NIDEK AFC-230 fundus camera, nonmydriatic.
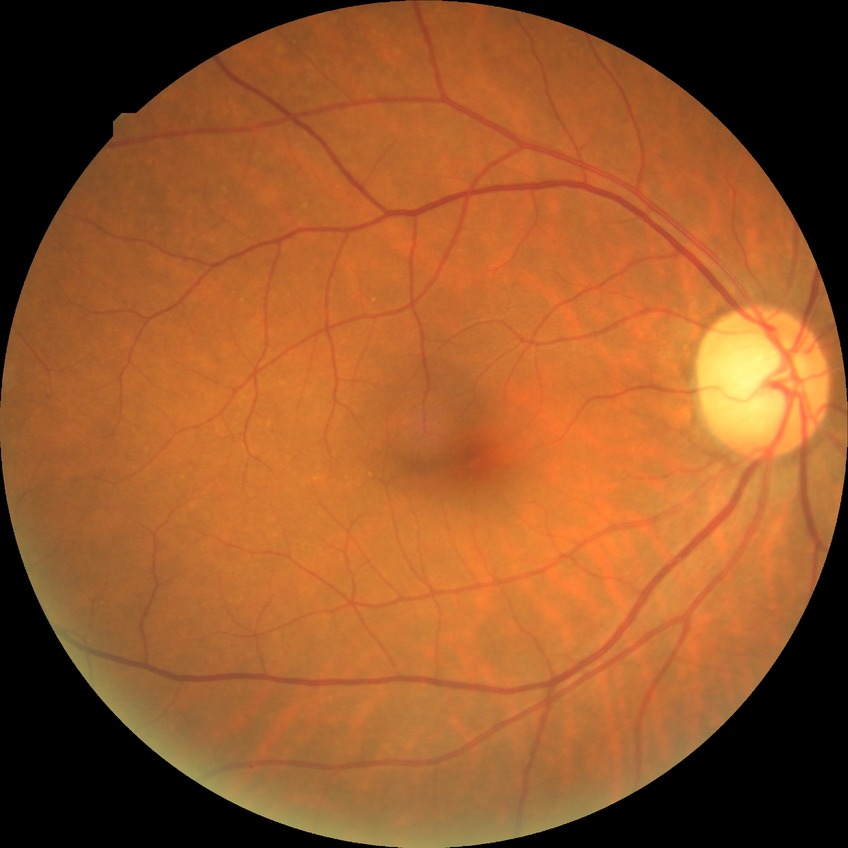
Diabetic retinopathy (DR) is NDR (no diabetic retinopathy).